Wide-field fundus image from infant ROP screening:
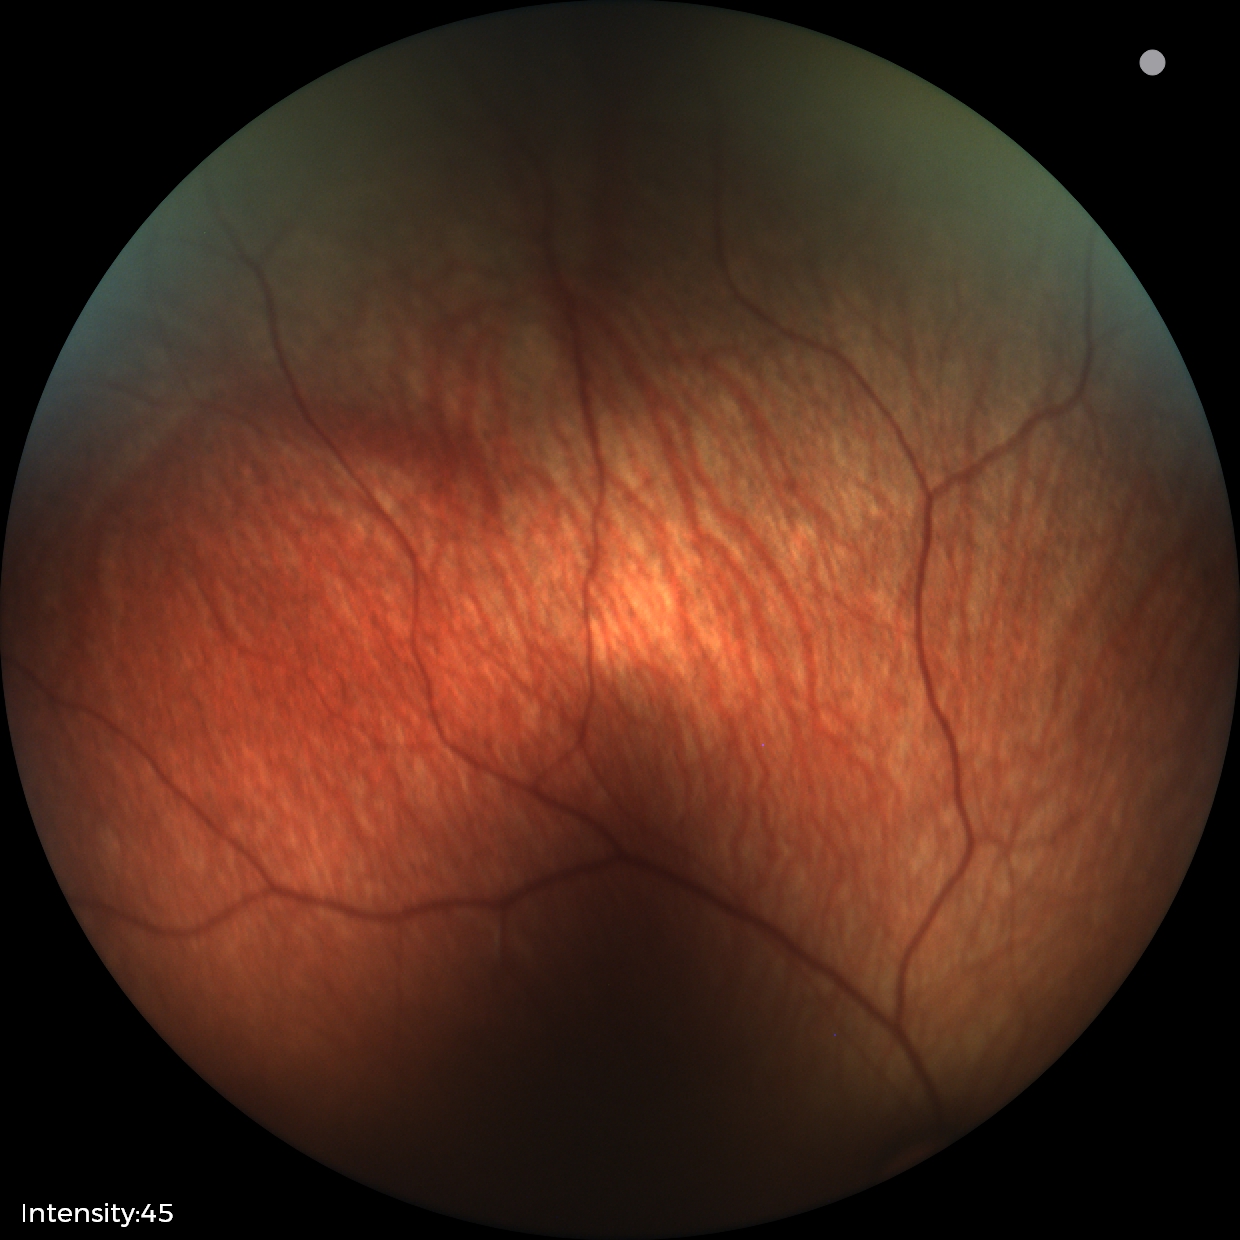
Screening: normal fundus examination.